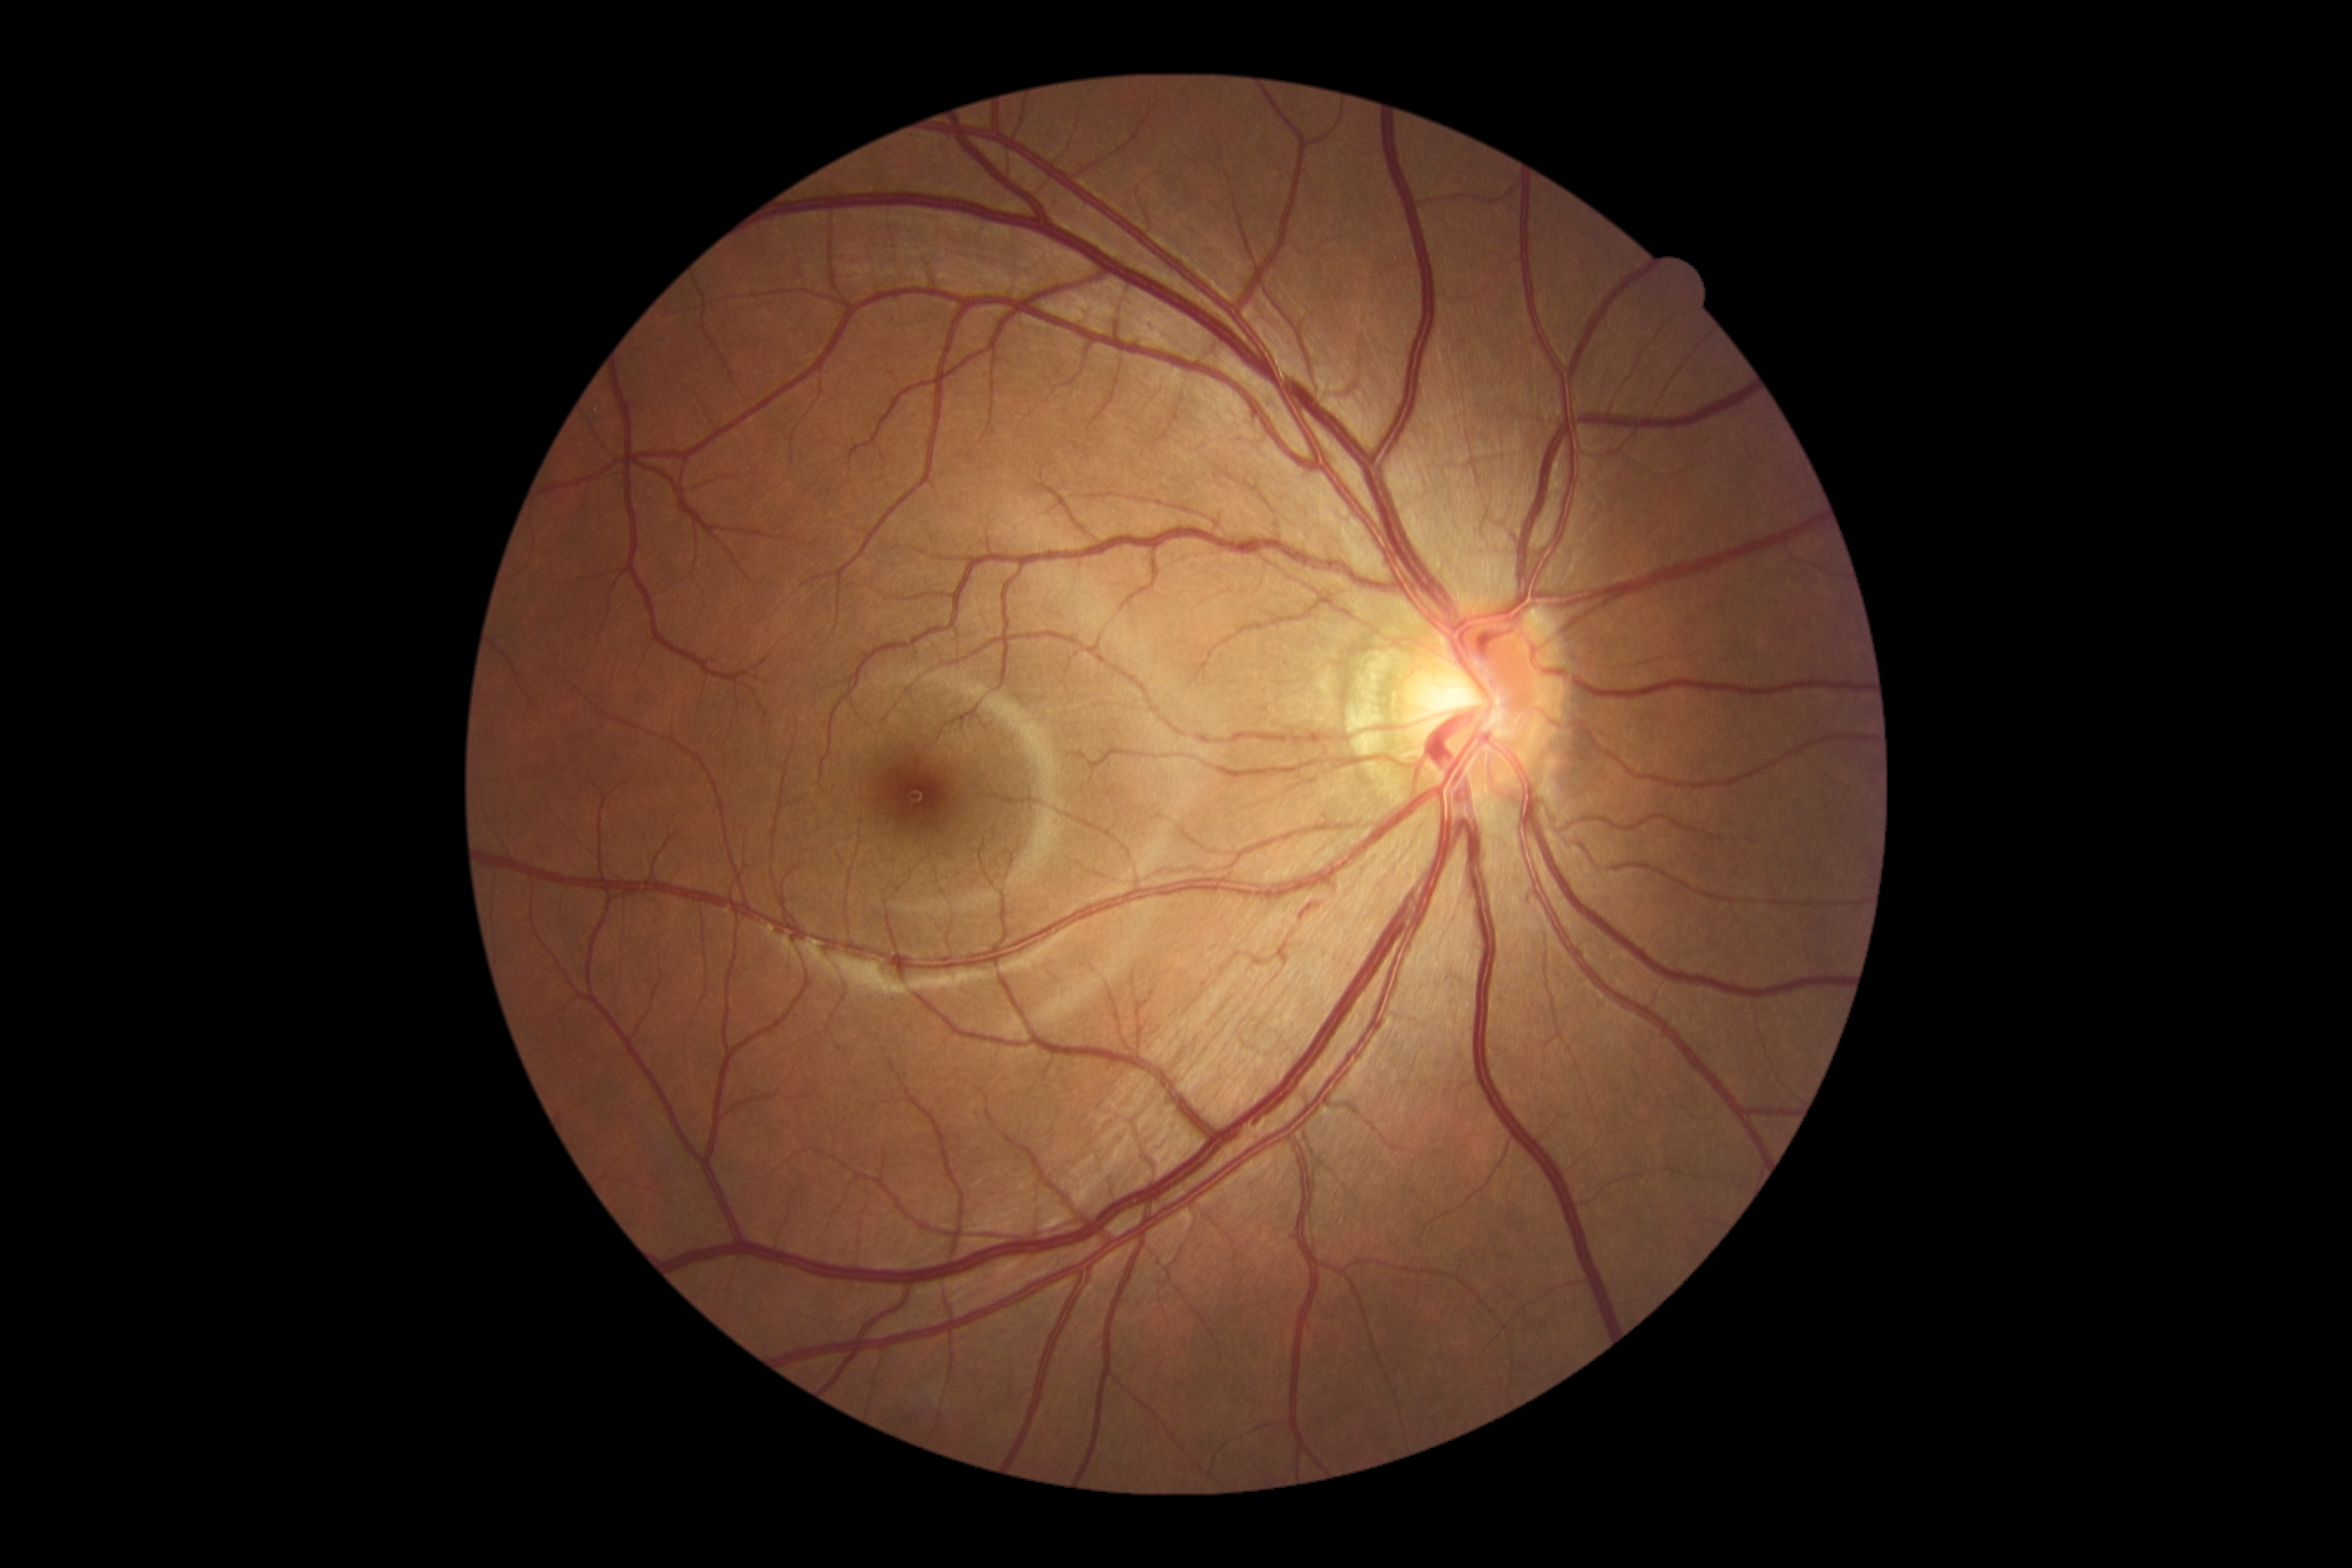

Diabetic retinopathy grade: 0 — no visible signs of diabetic retinopathy.
No apparent diabetic retinopathy.